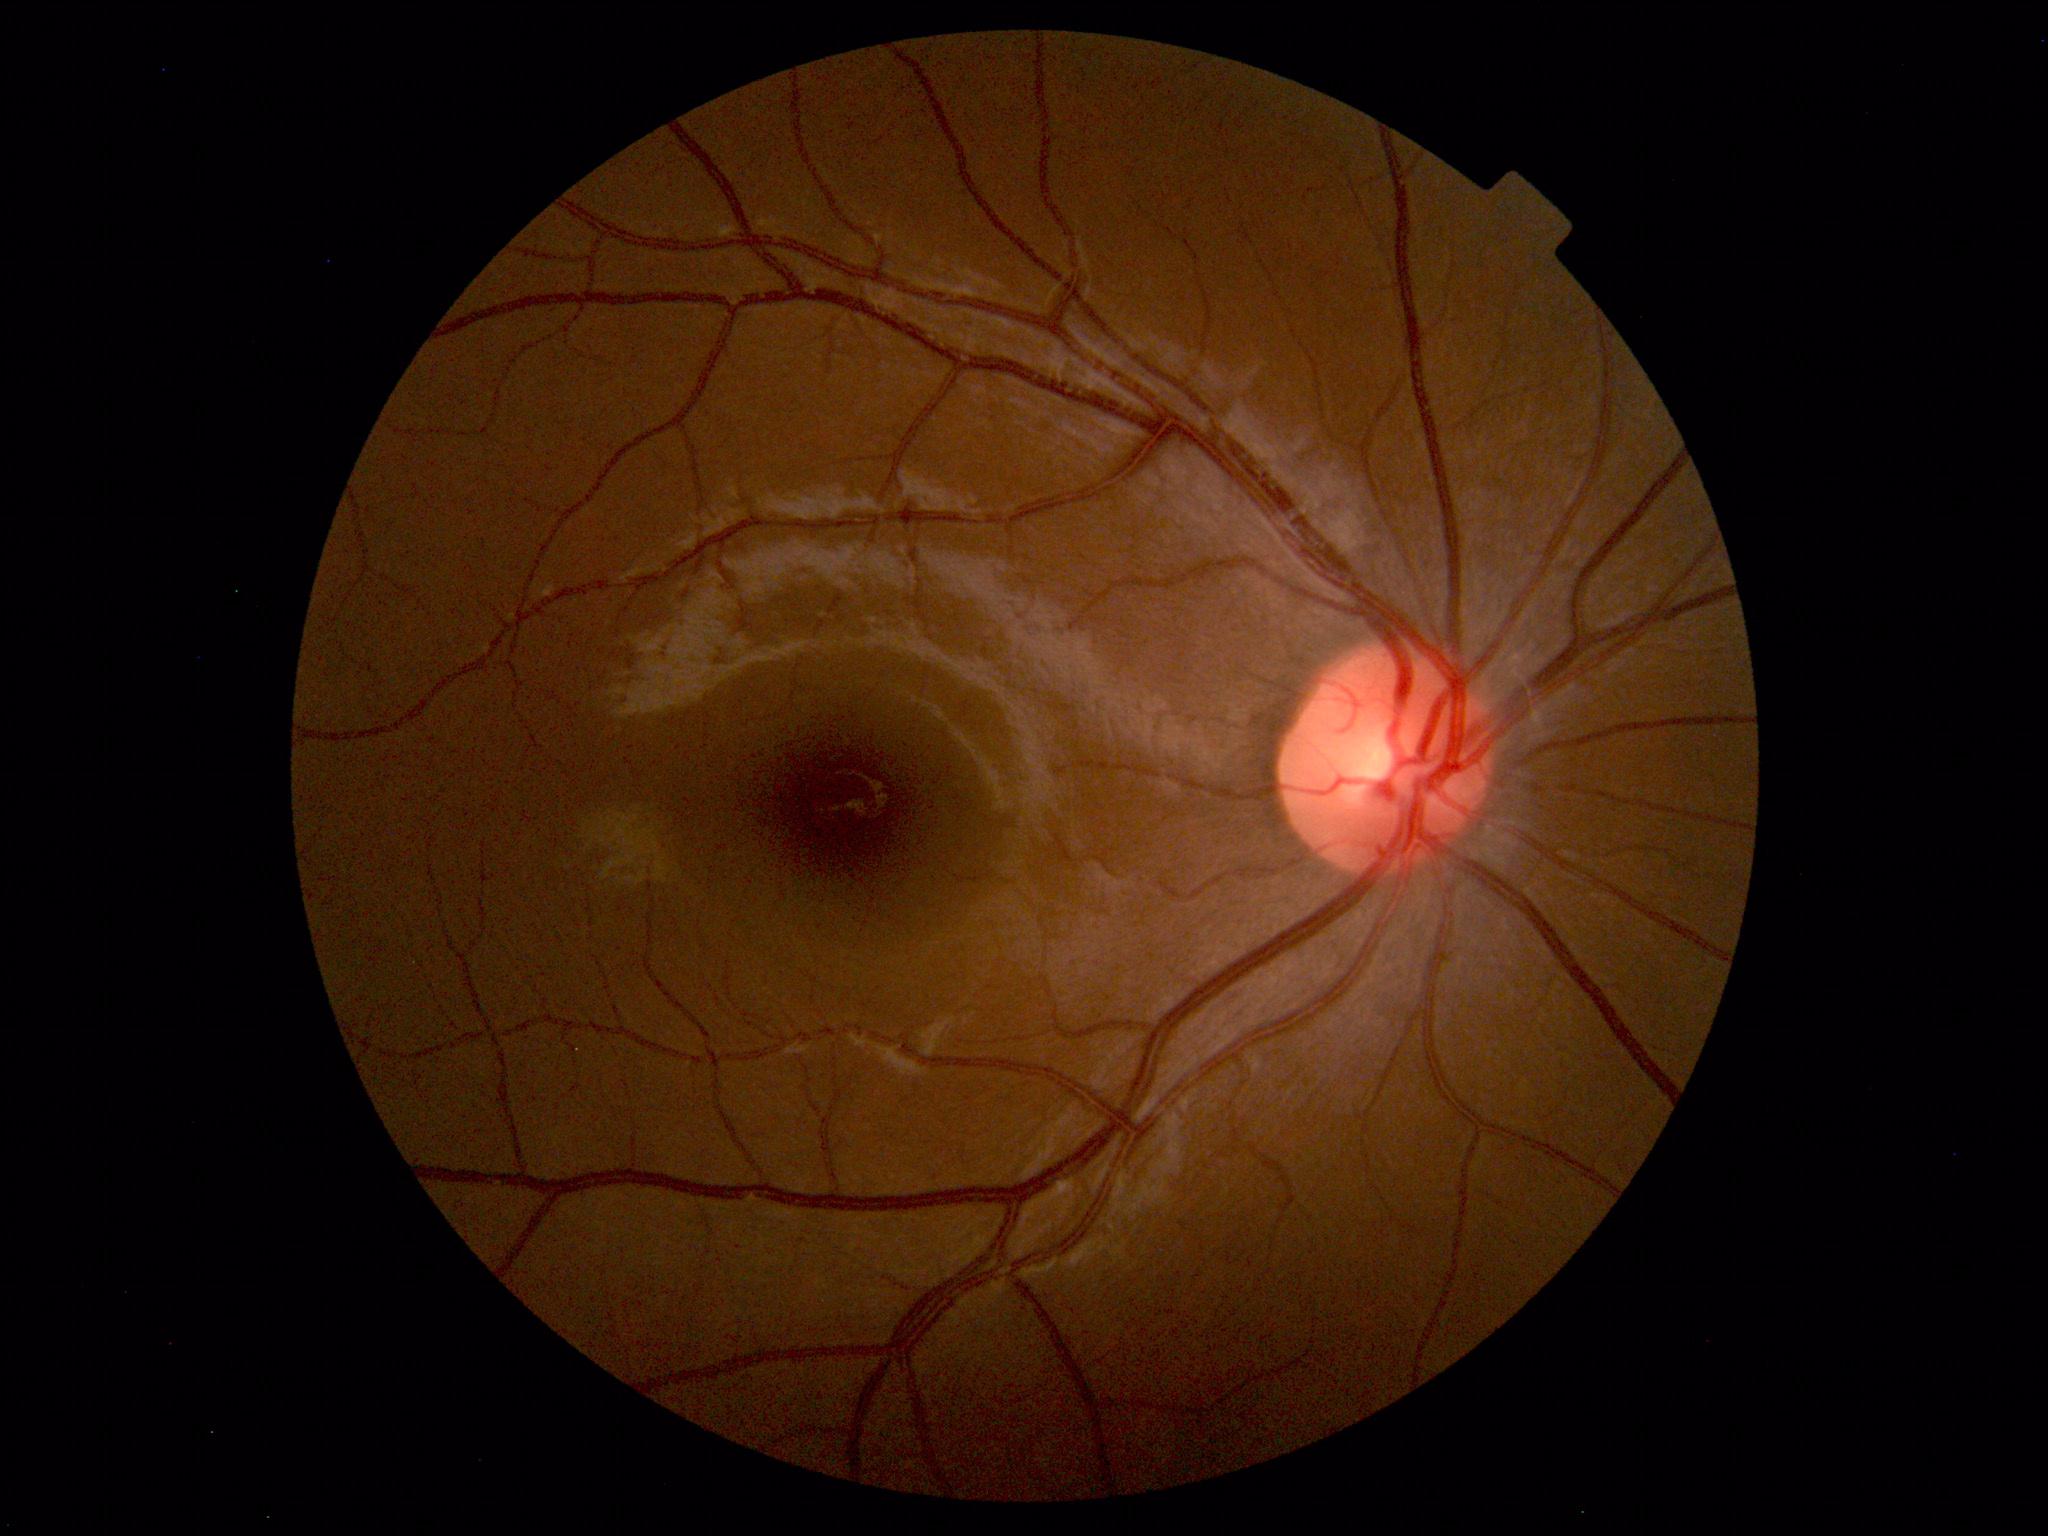 No abnormal findings on fundus examination.